848 by 848 pixels; nonmydriatic fundus photograph.
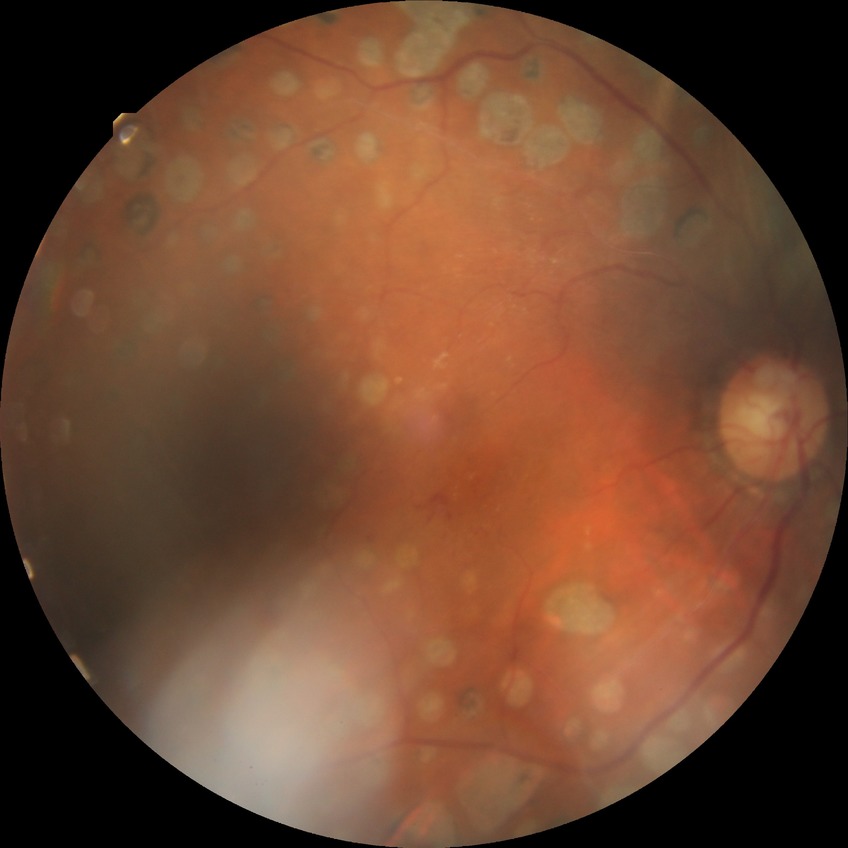 Annotations:
– diabetic retinopathy (DR): proliferative diabetic retinopathy (PDR)